CFP. 1536x1152px. 45° field of view — 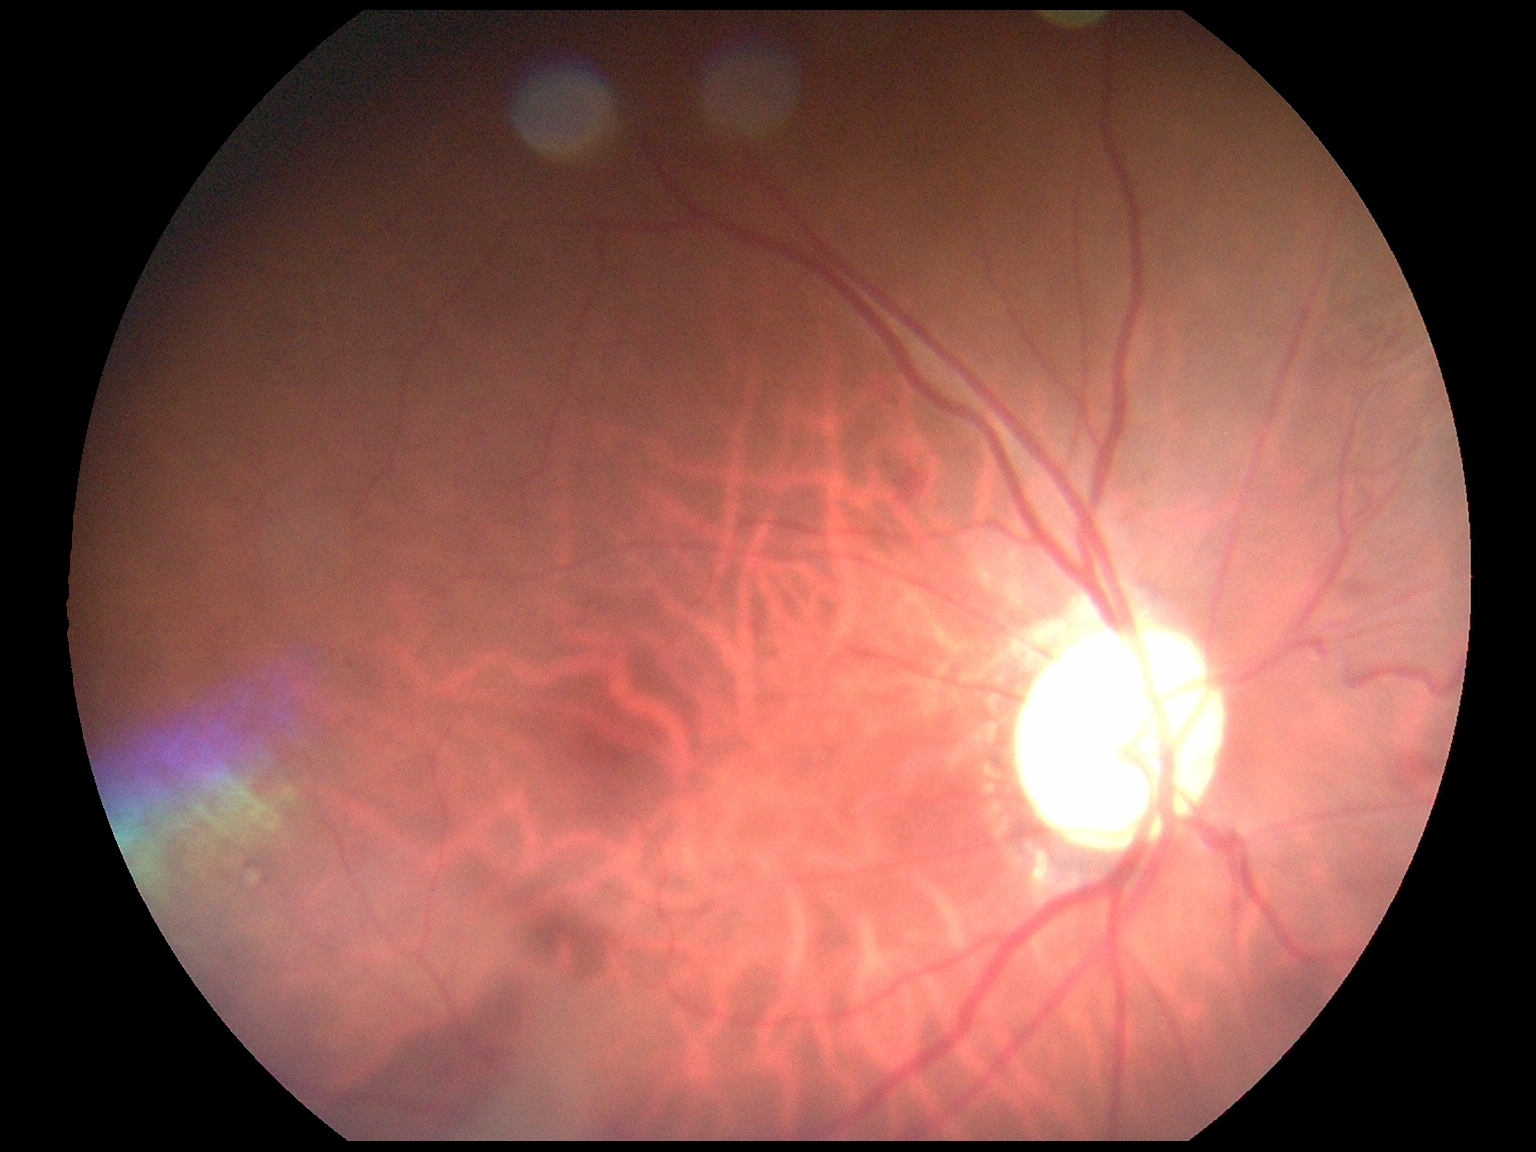

- retinopathy: grade 2 (moderate NPDR)